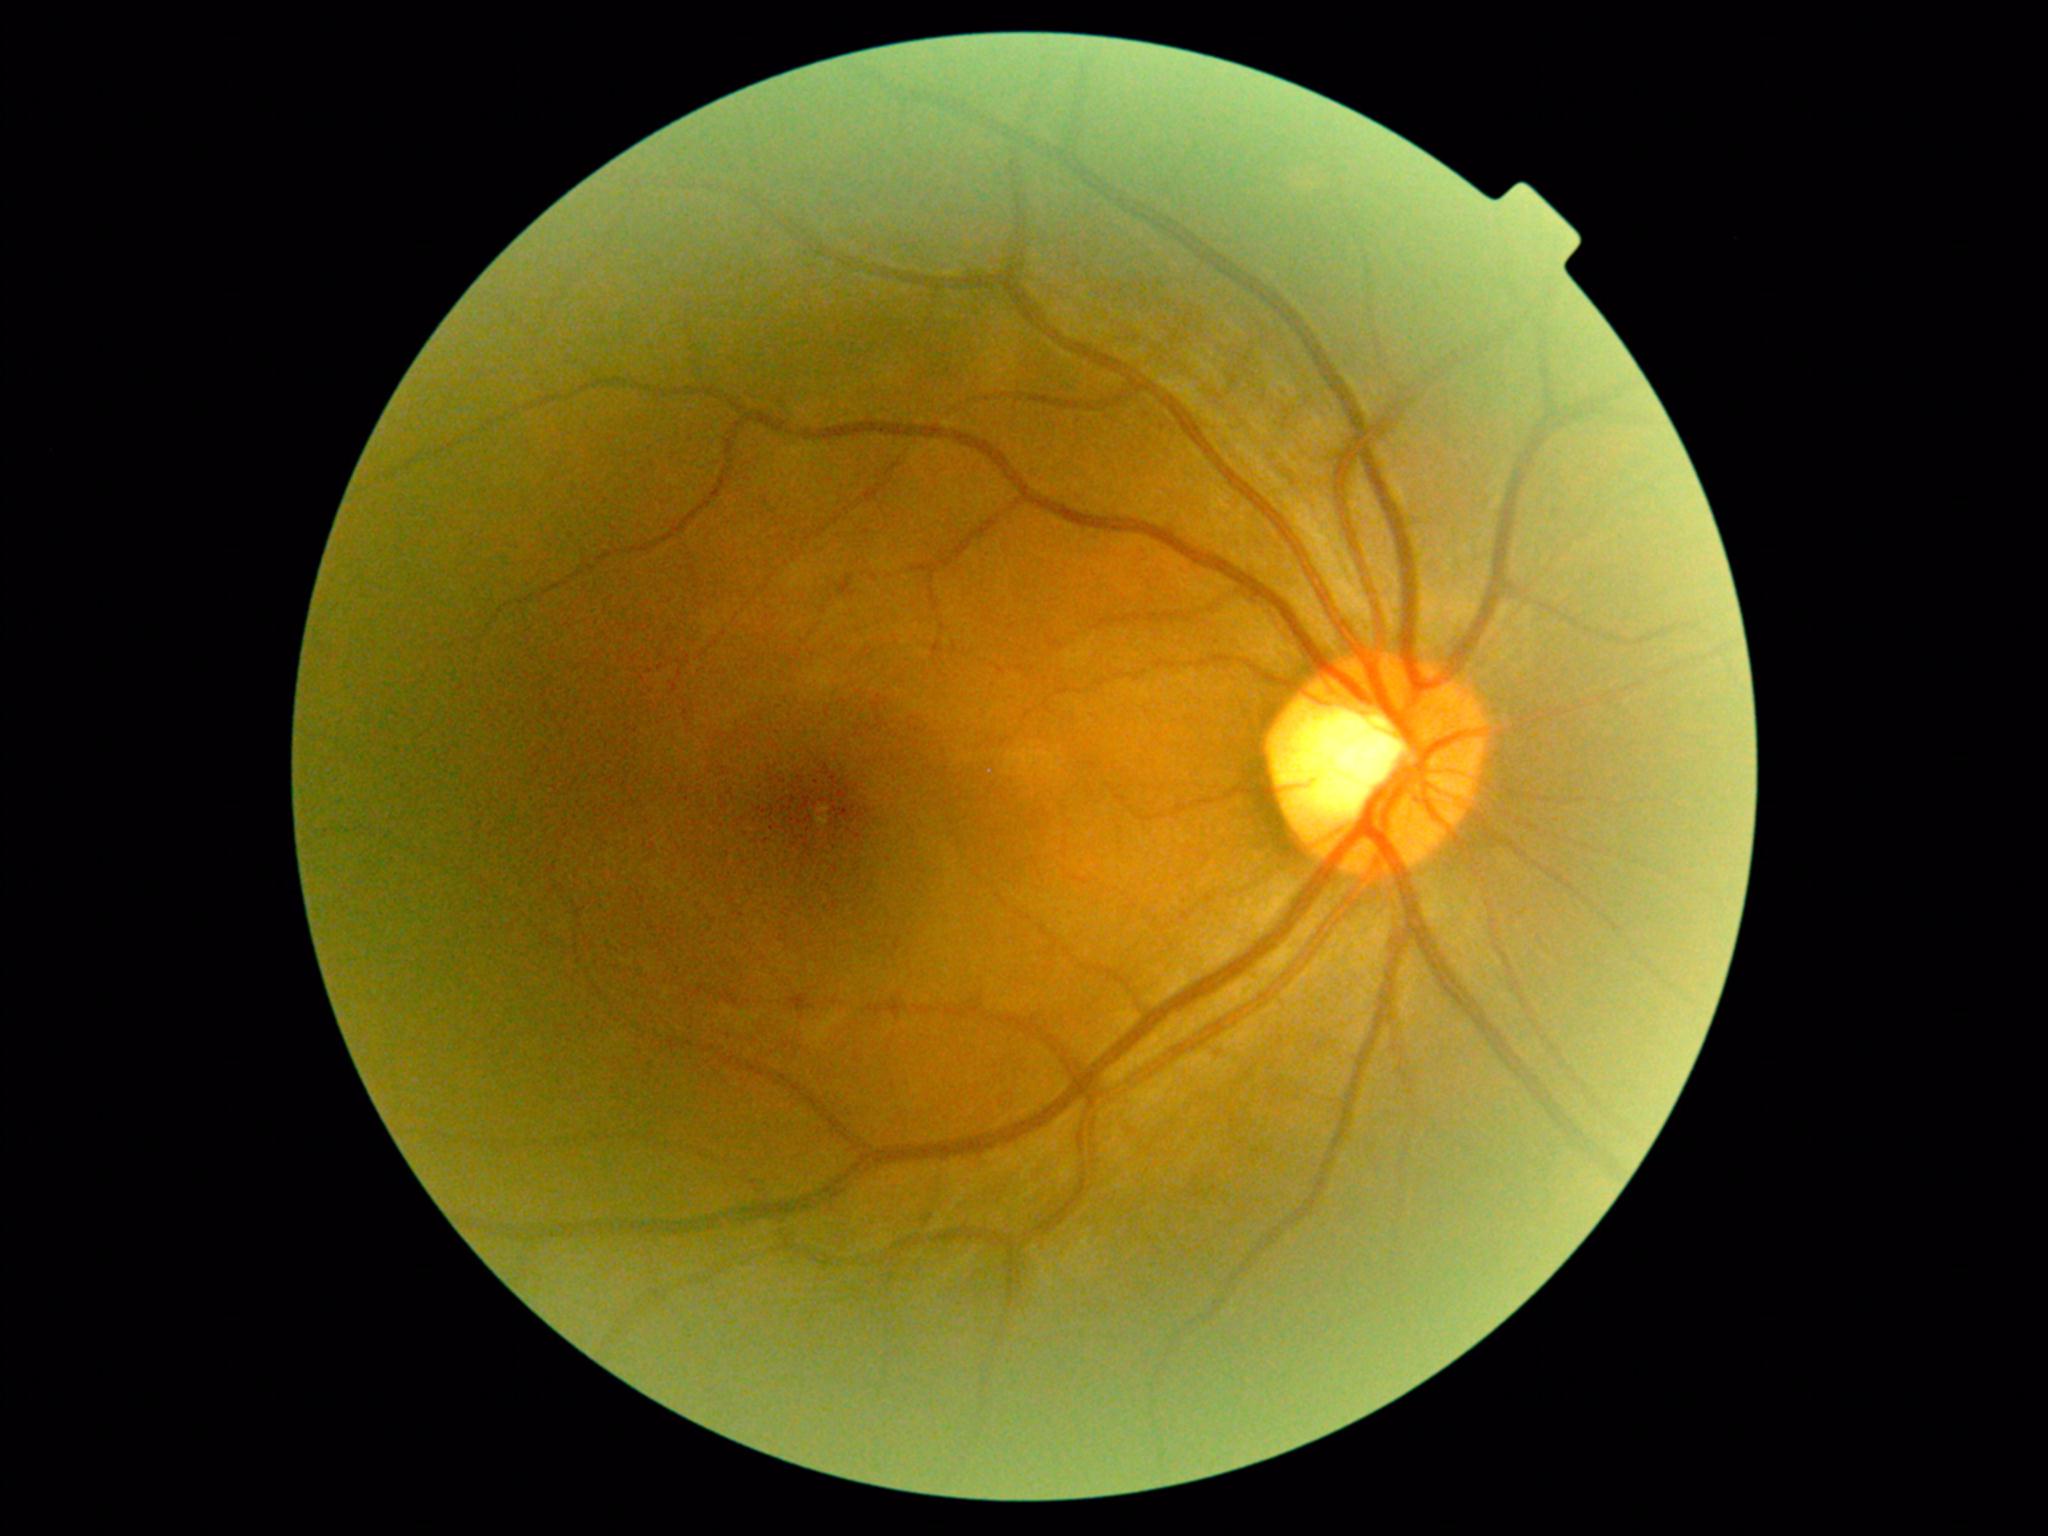   dr_grade: 0 (no apparent retinopathy)